45° FOV. Fundus photo
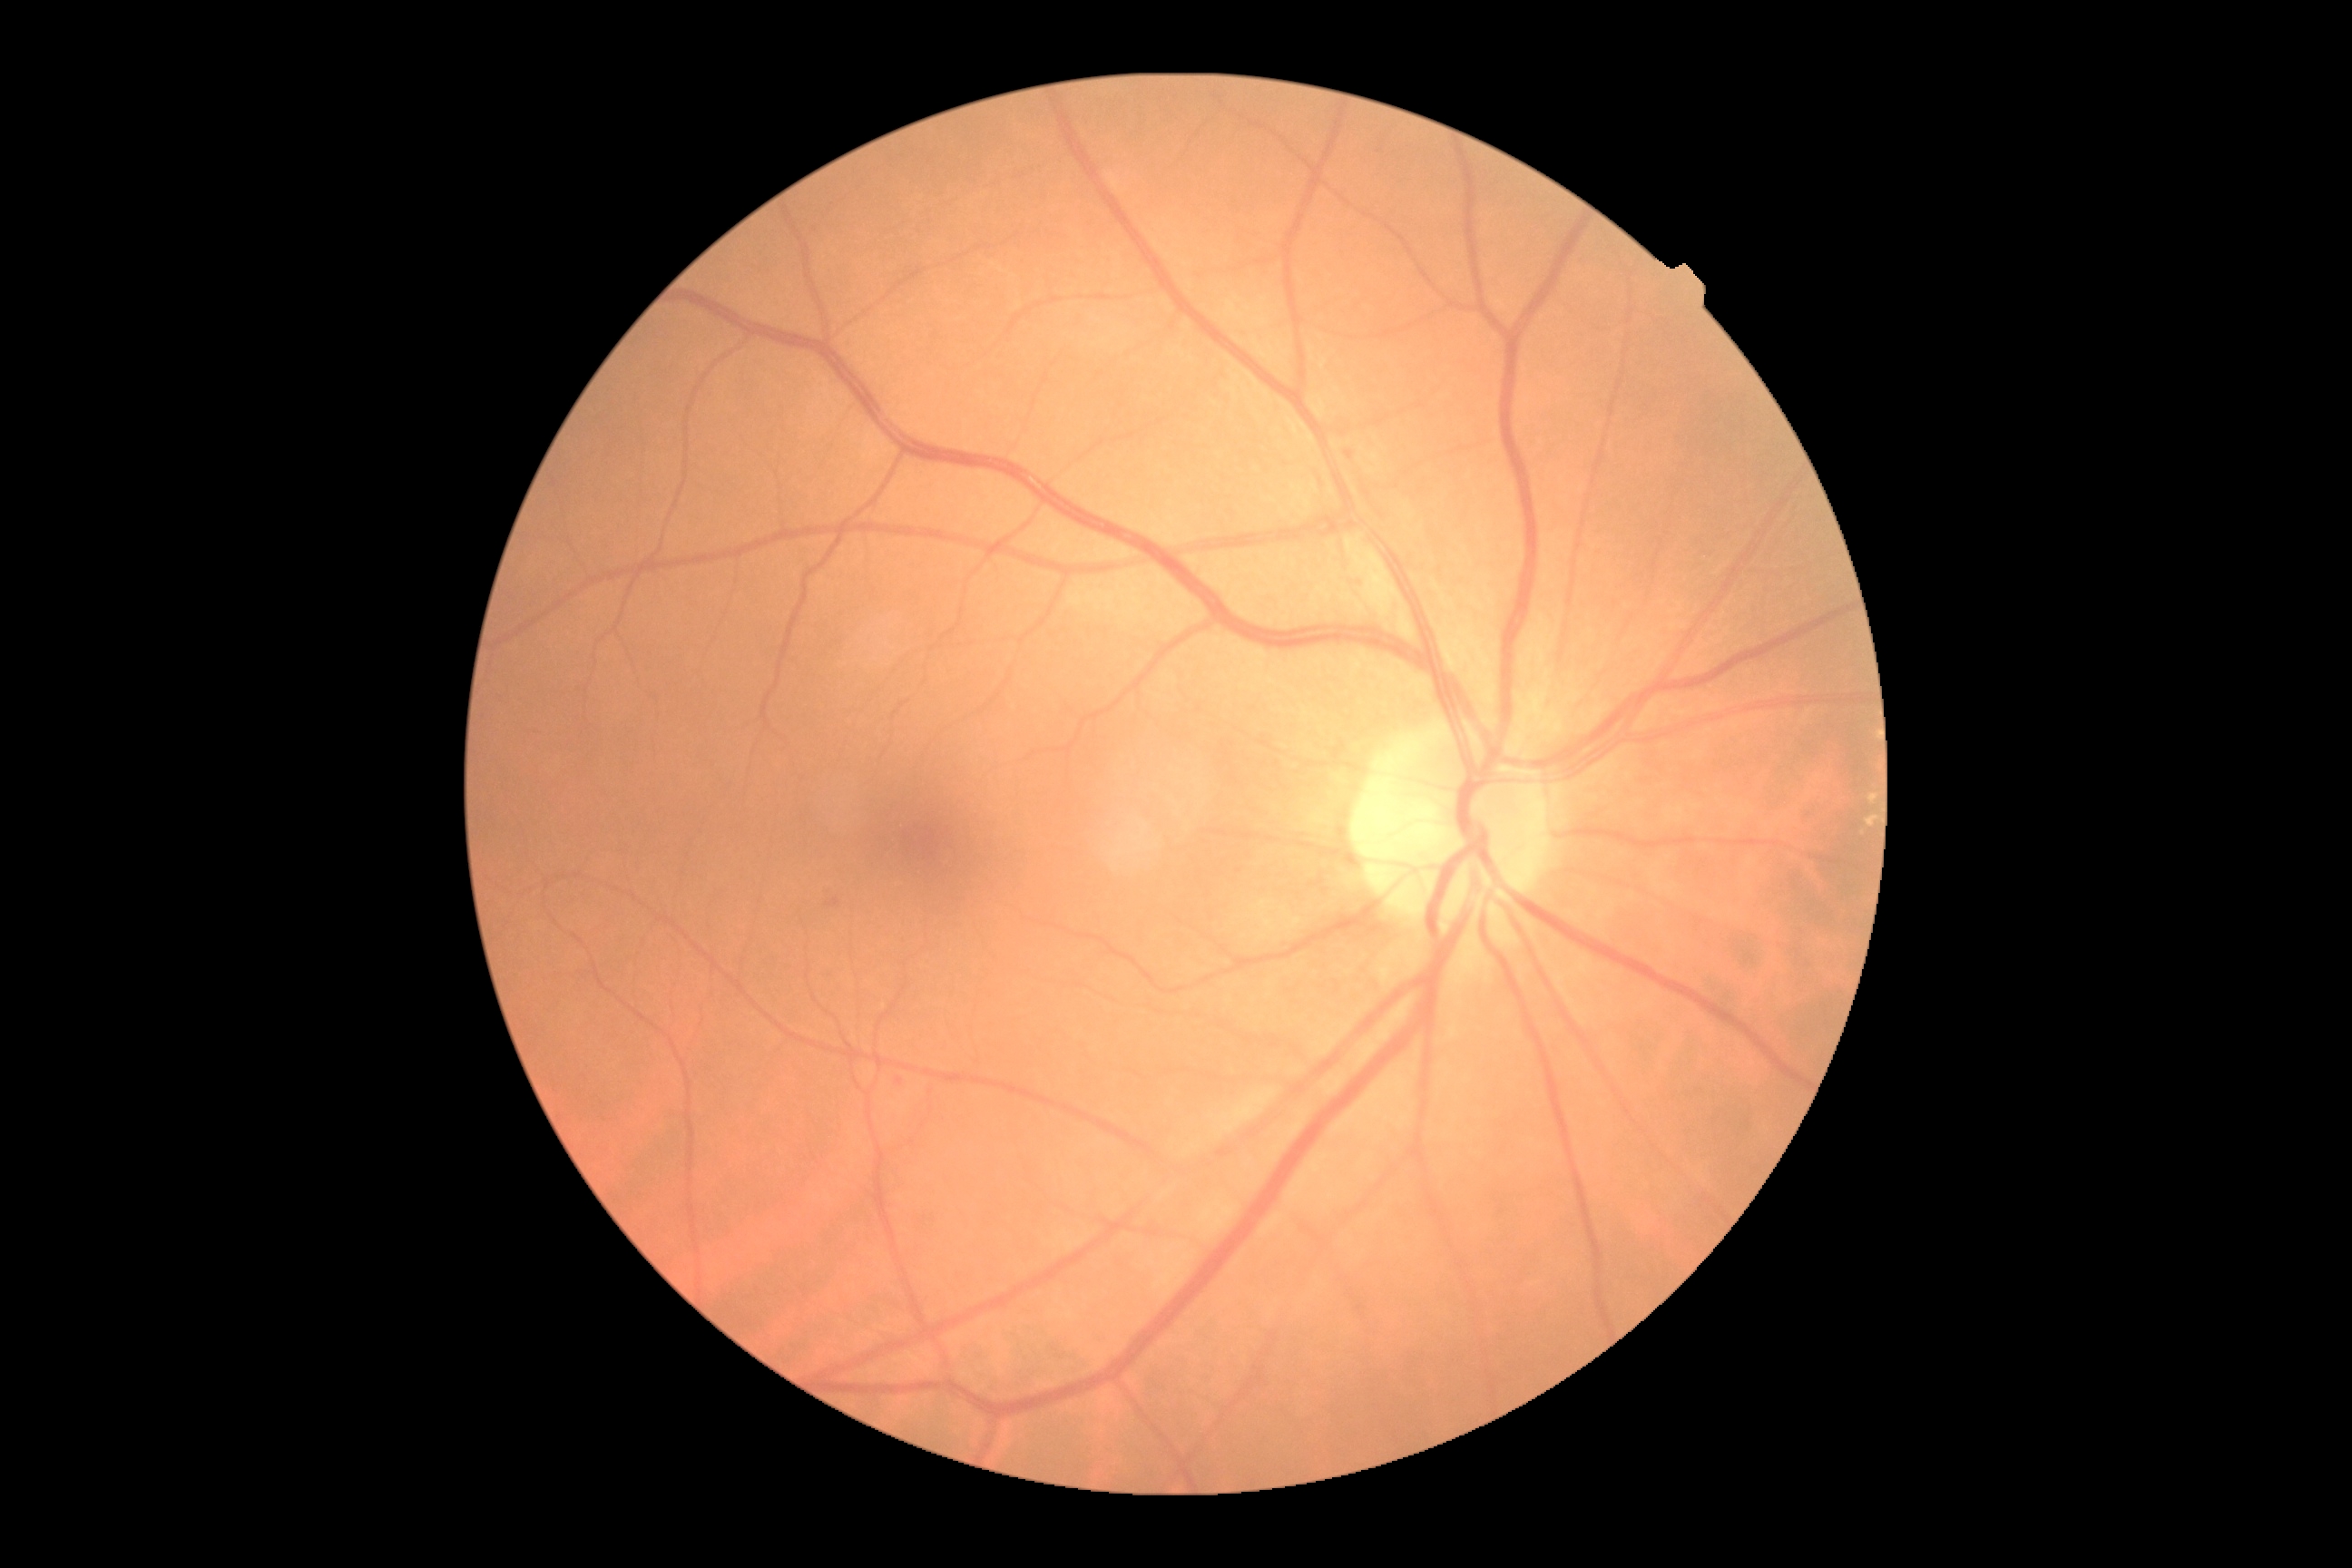

Diabetic retinopathy (DR) is grade 2.